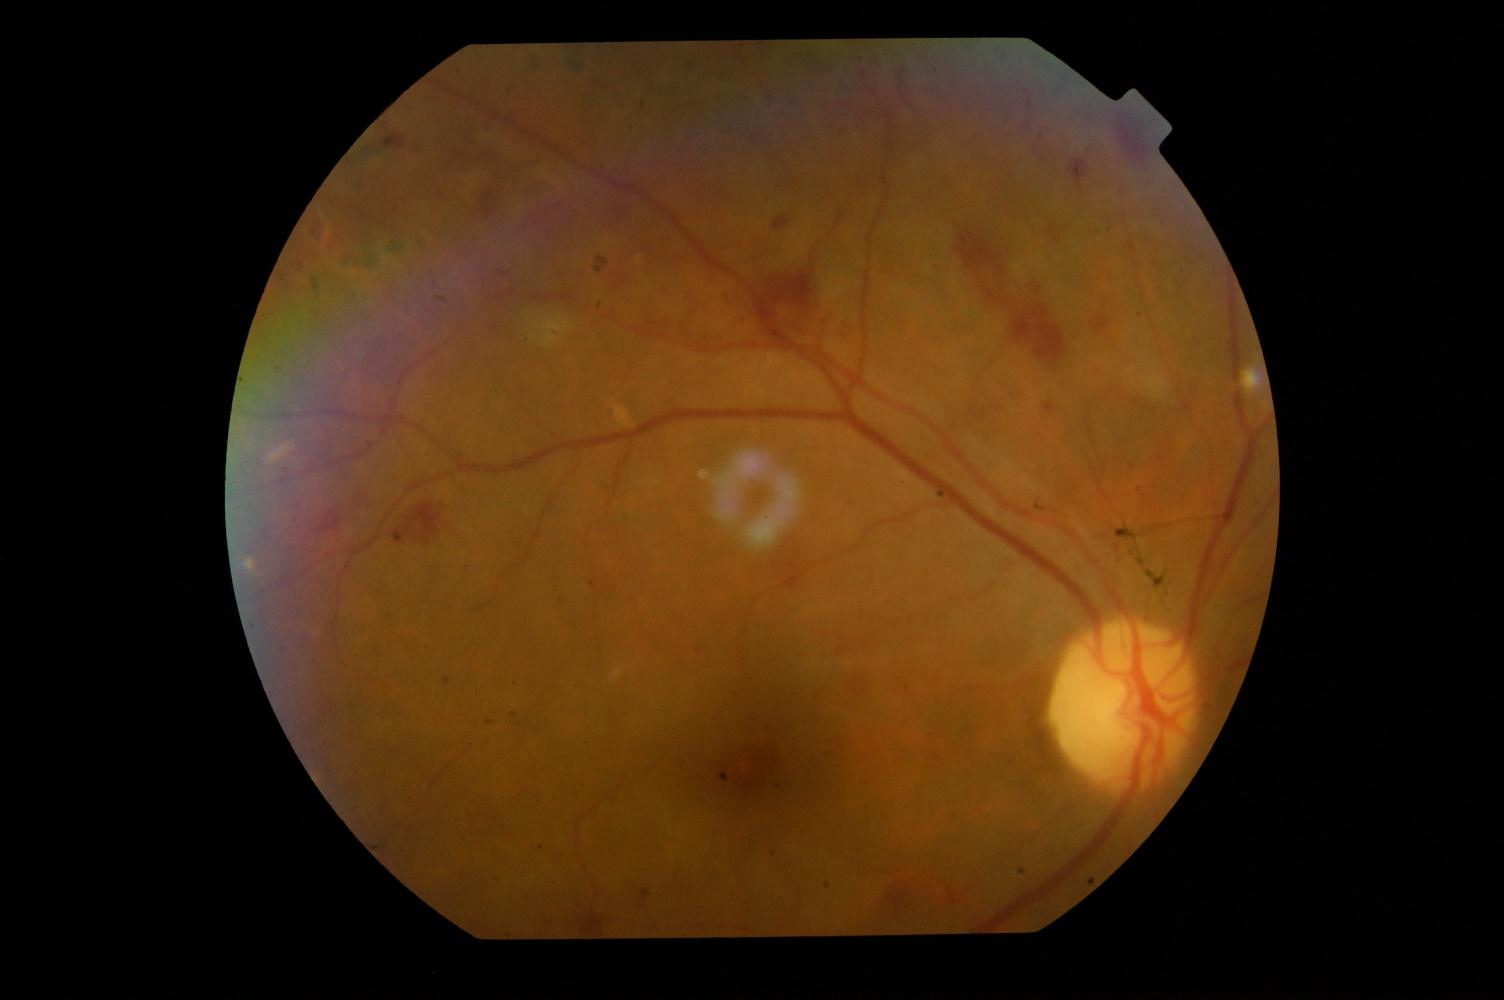
Color fundus photograph showing DR (diabetic retinopathy).